848x848; no pharmacologic dilation; NIDEK AFC-230; CFP.
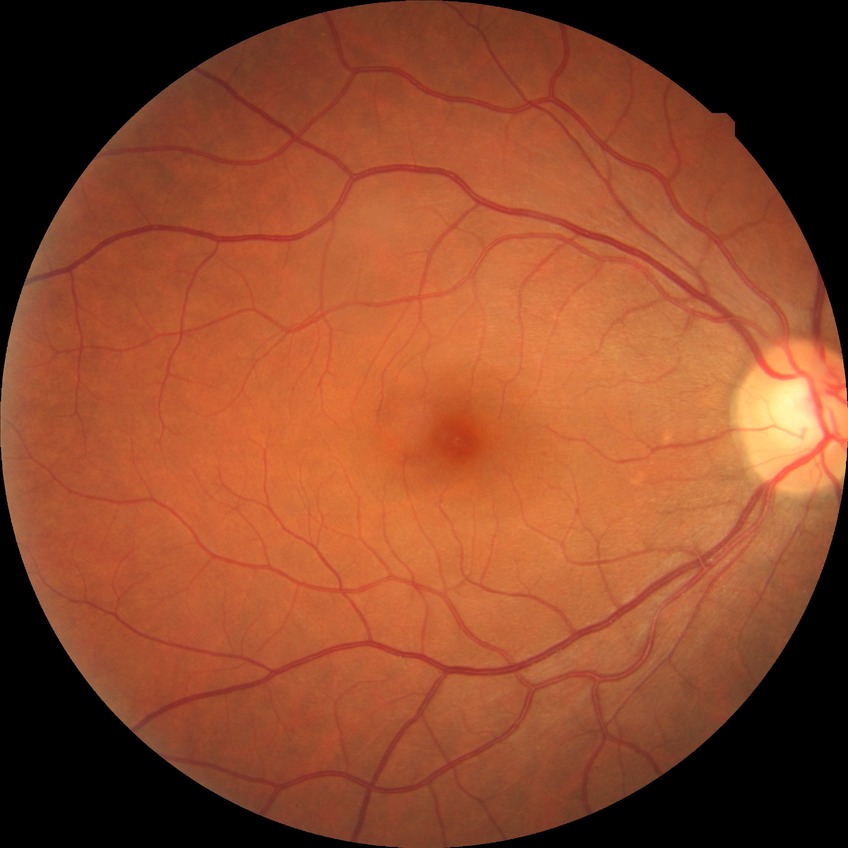 DR stage = NDR.